Remidio FOP fundus camera; retinal fundus photograph: 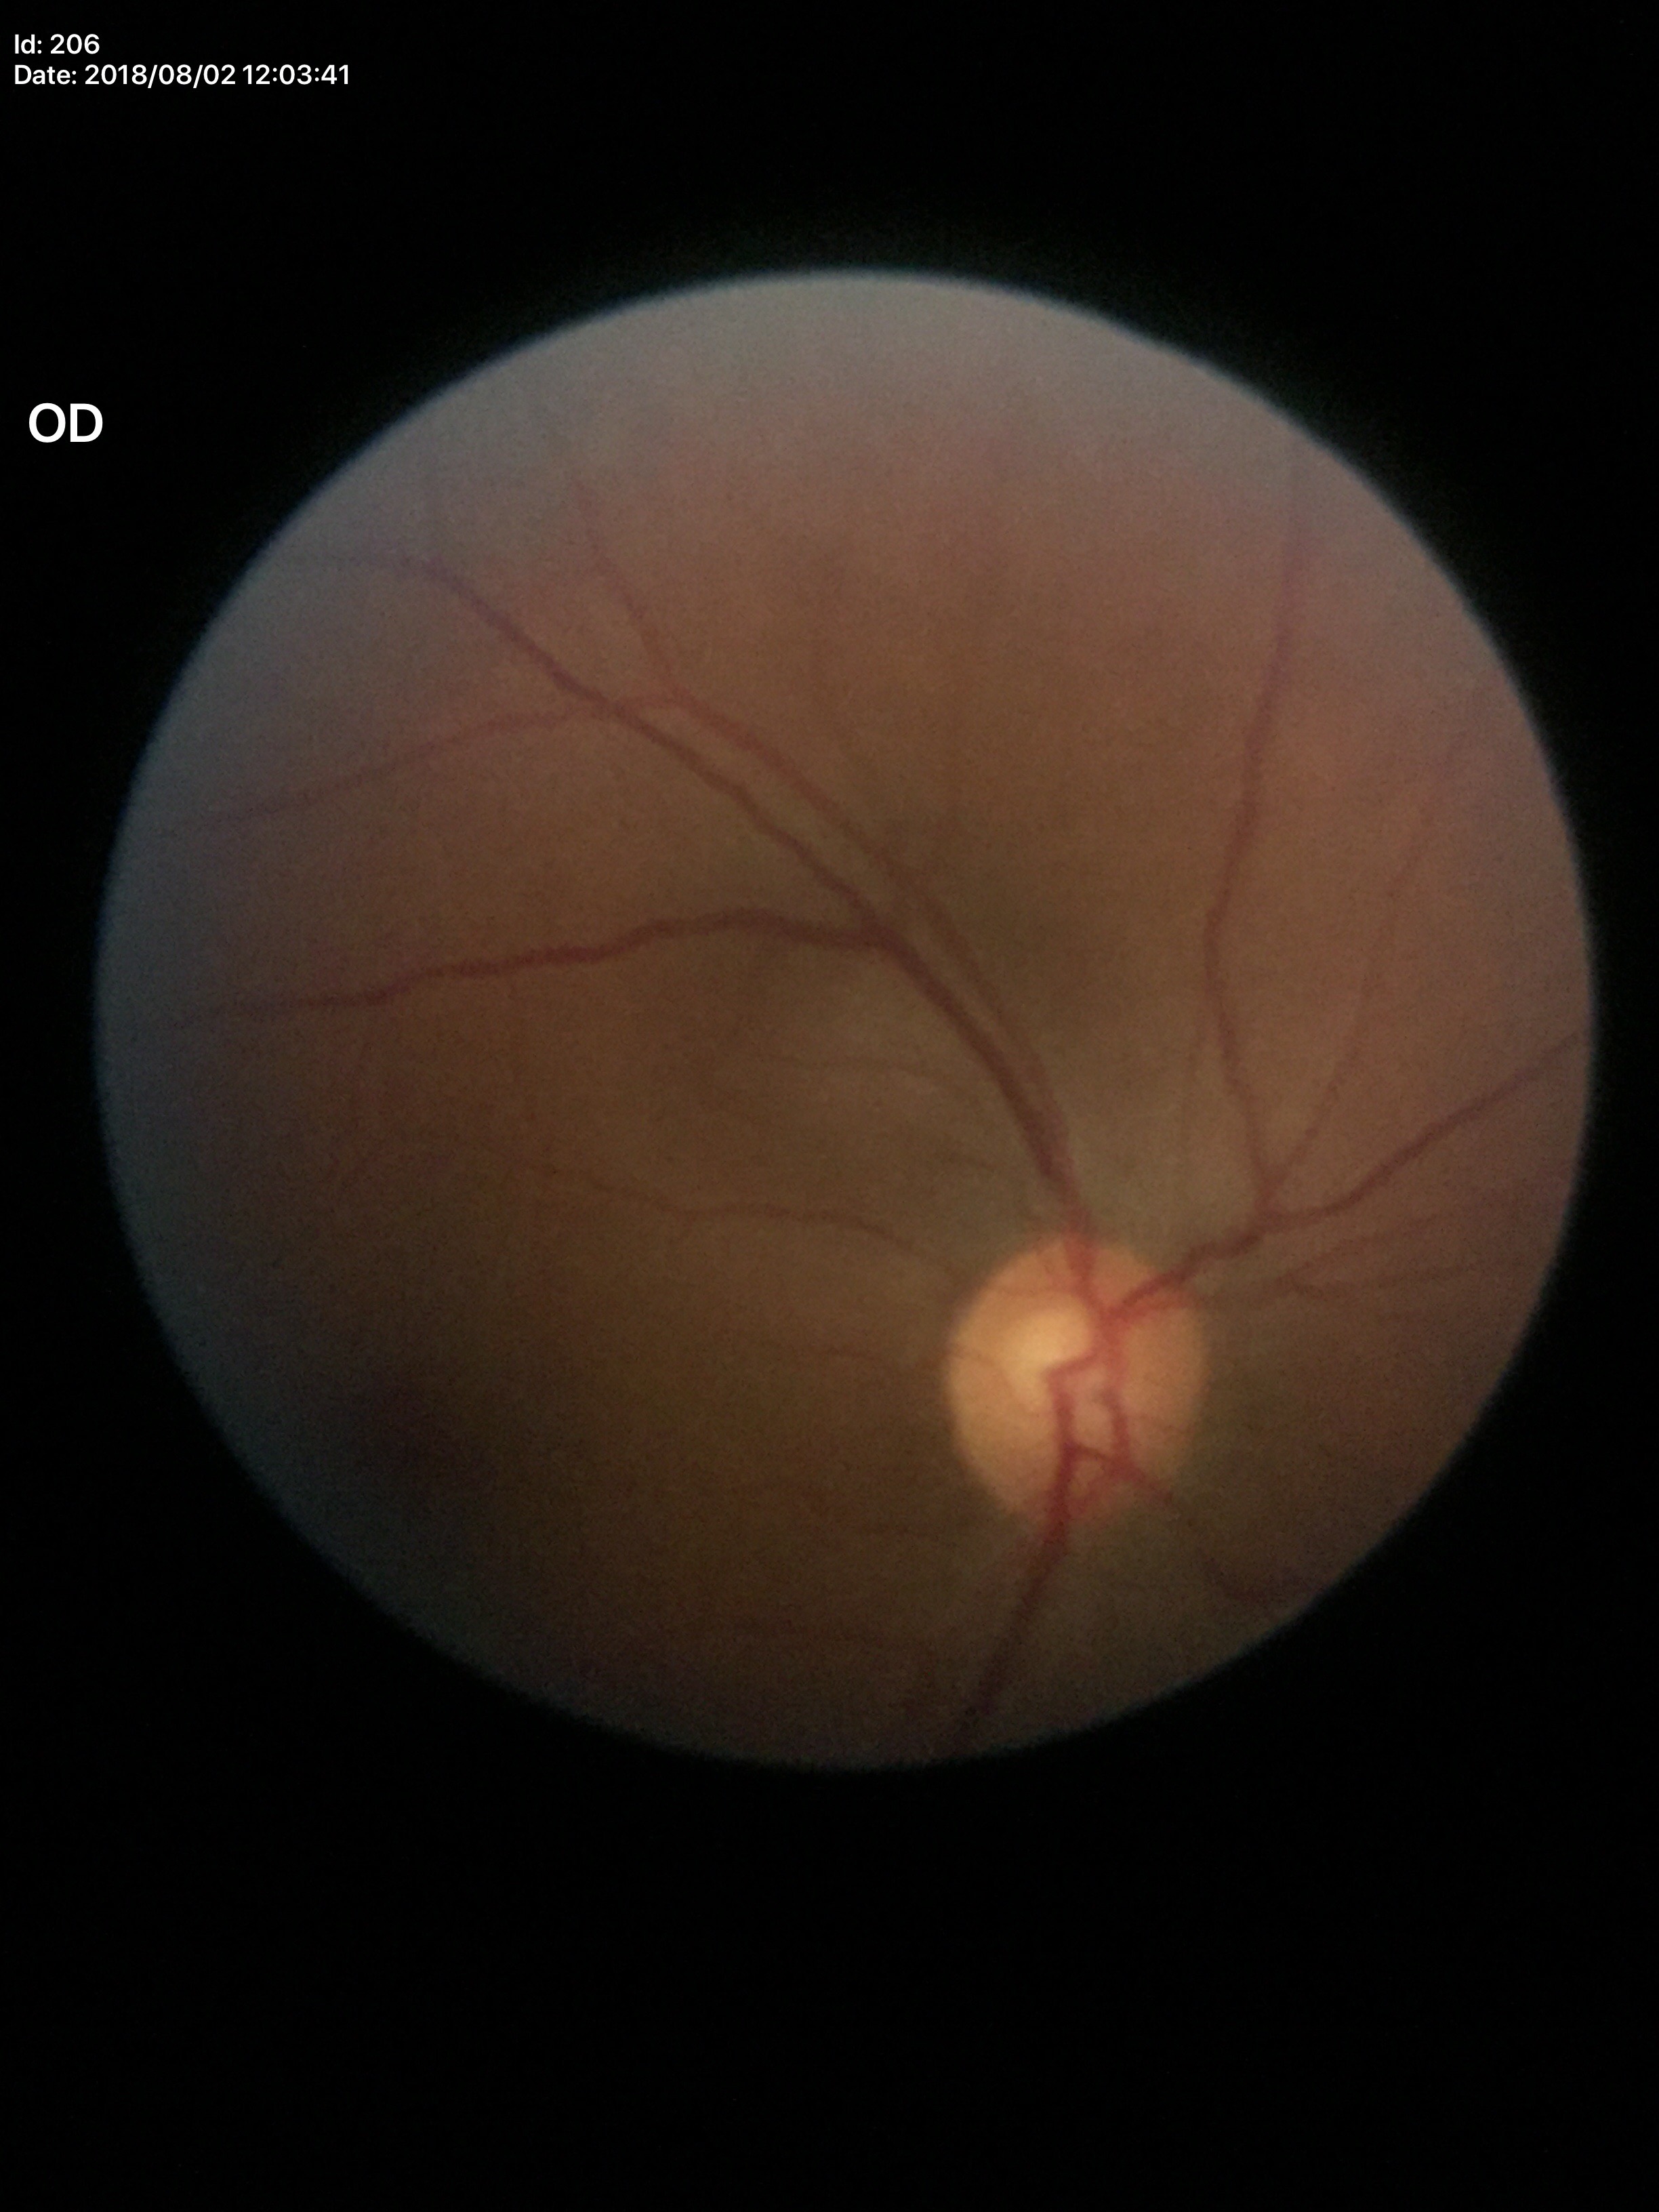 Negative for glaucoma suspicion (one of five ophthalmologists flagged glaucoma suspect).
Vertical cup-to-disc ratio: 0.56.